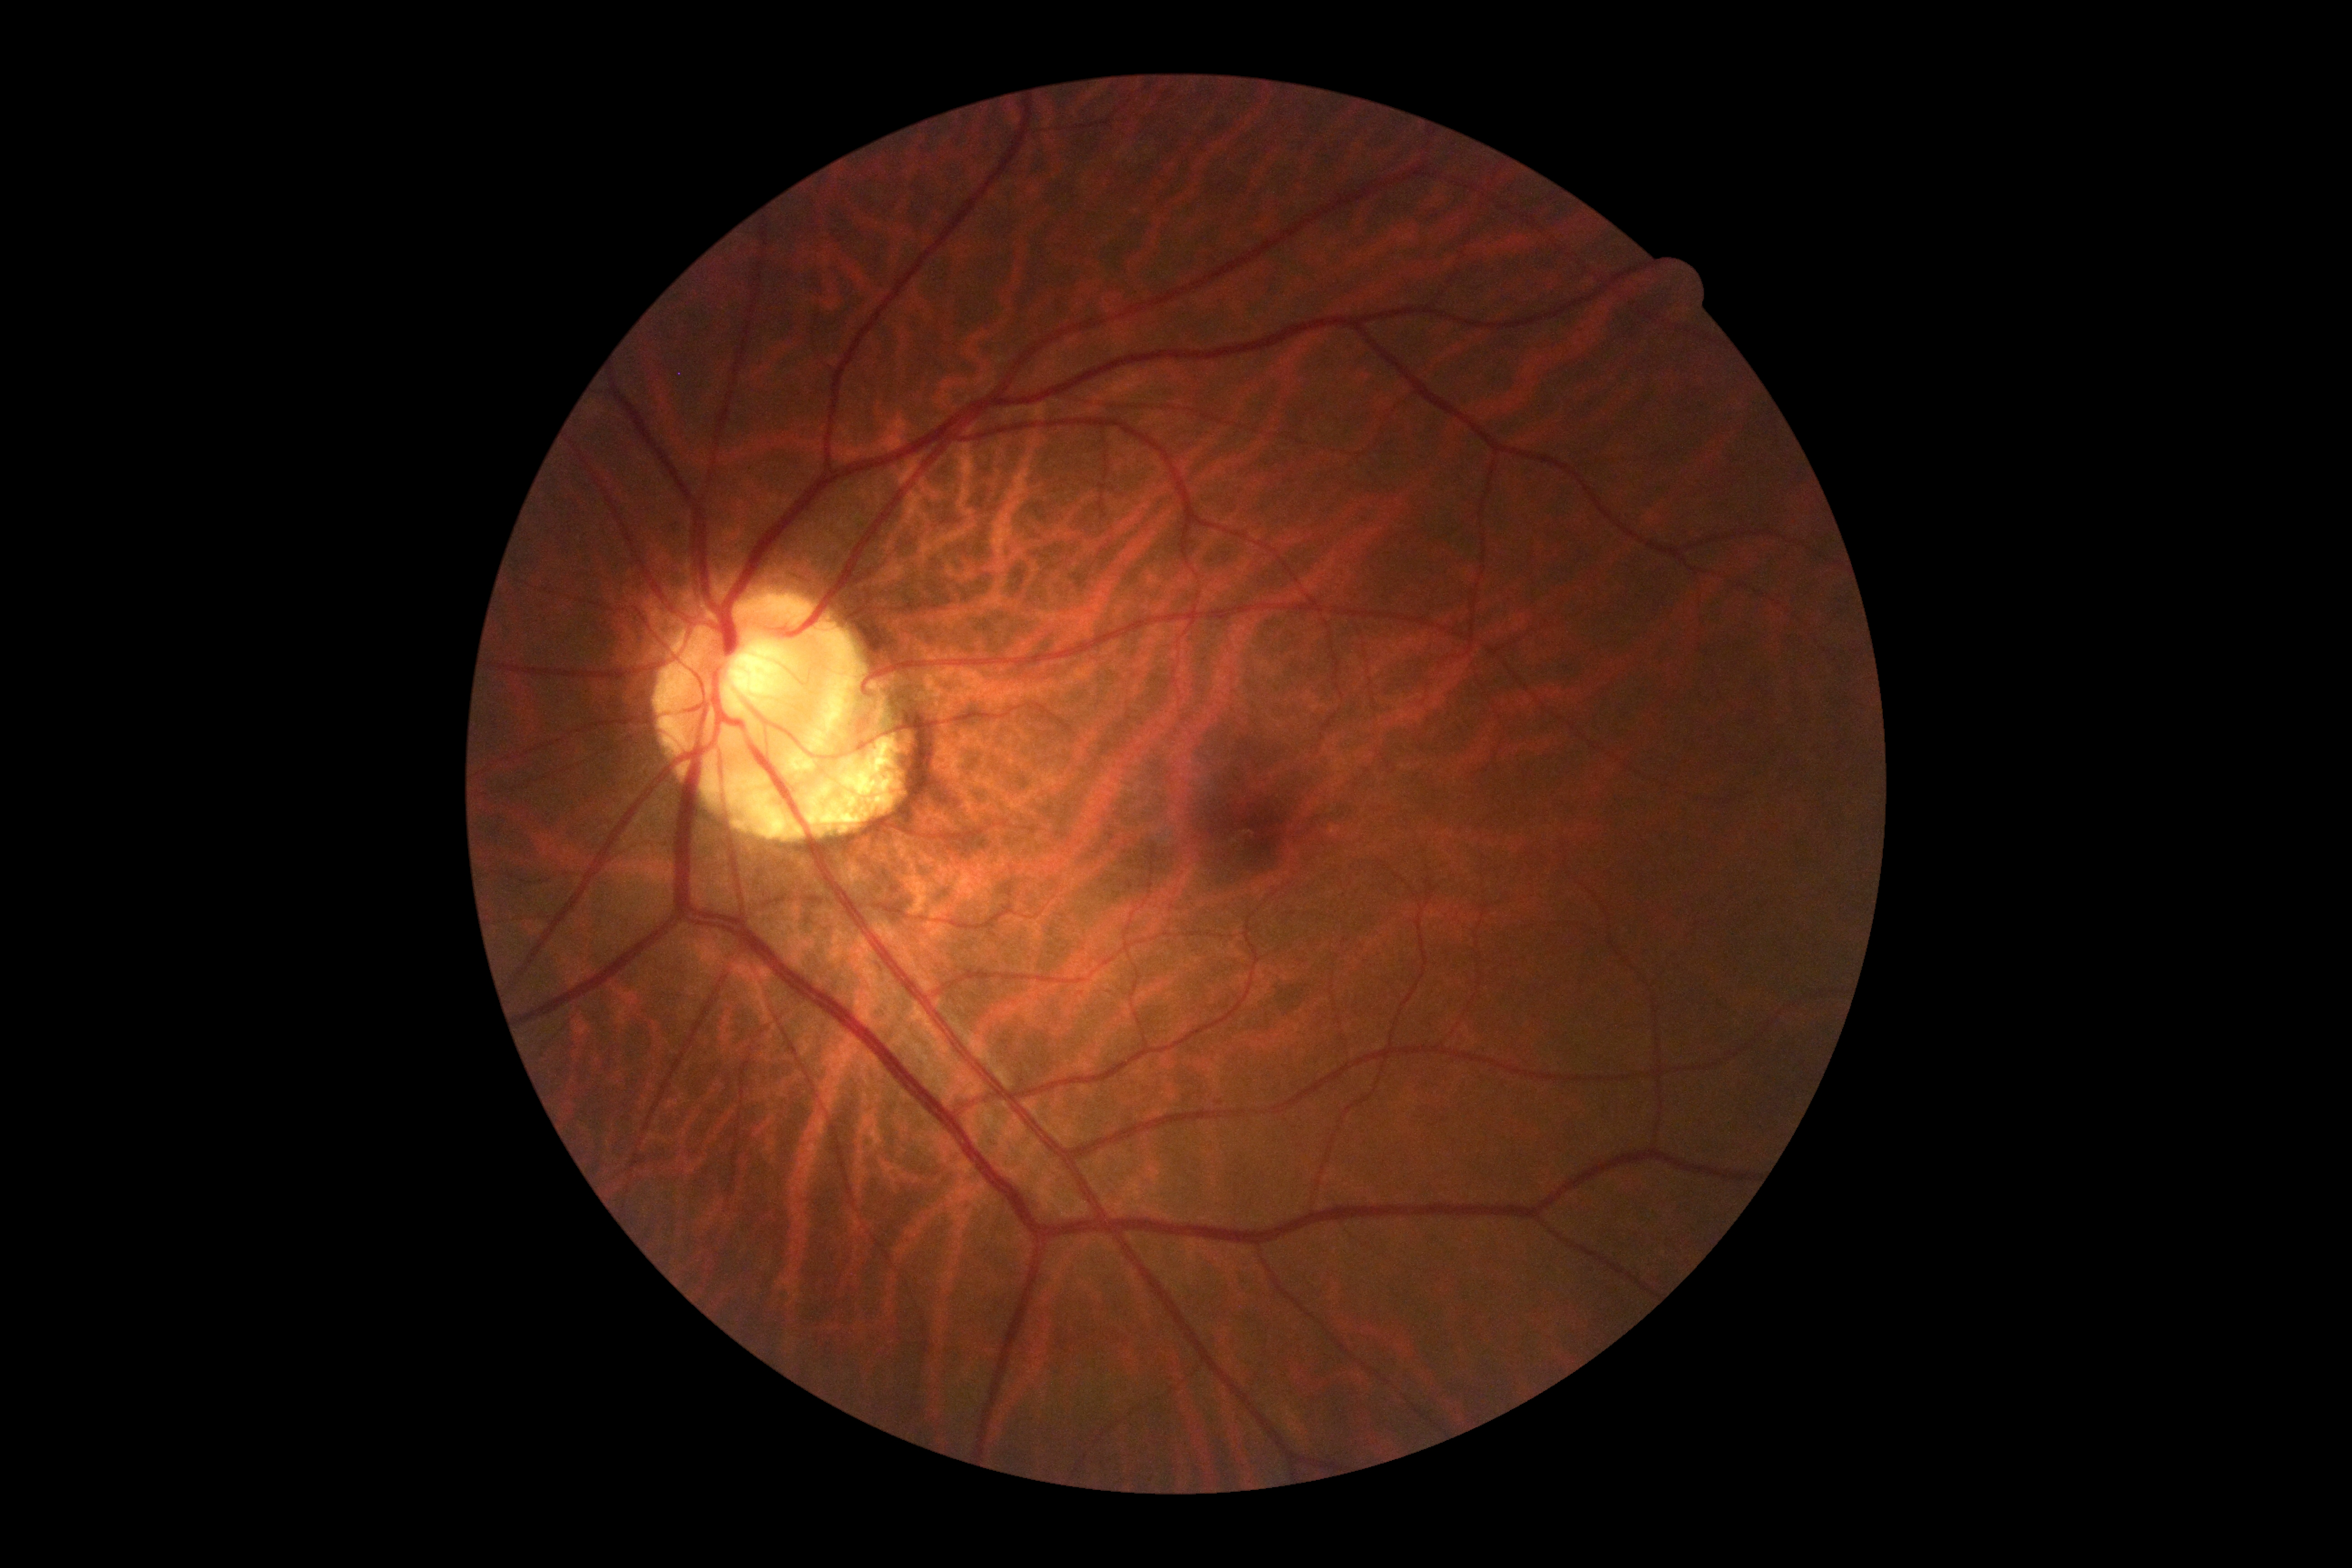
dr_grade: grade 0 (no apparent retinopathy)
dr_impression: no DR findings